Pediatric retinal photograph (wide-field):
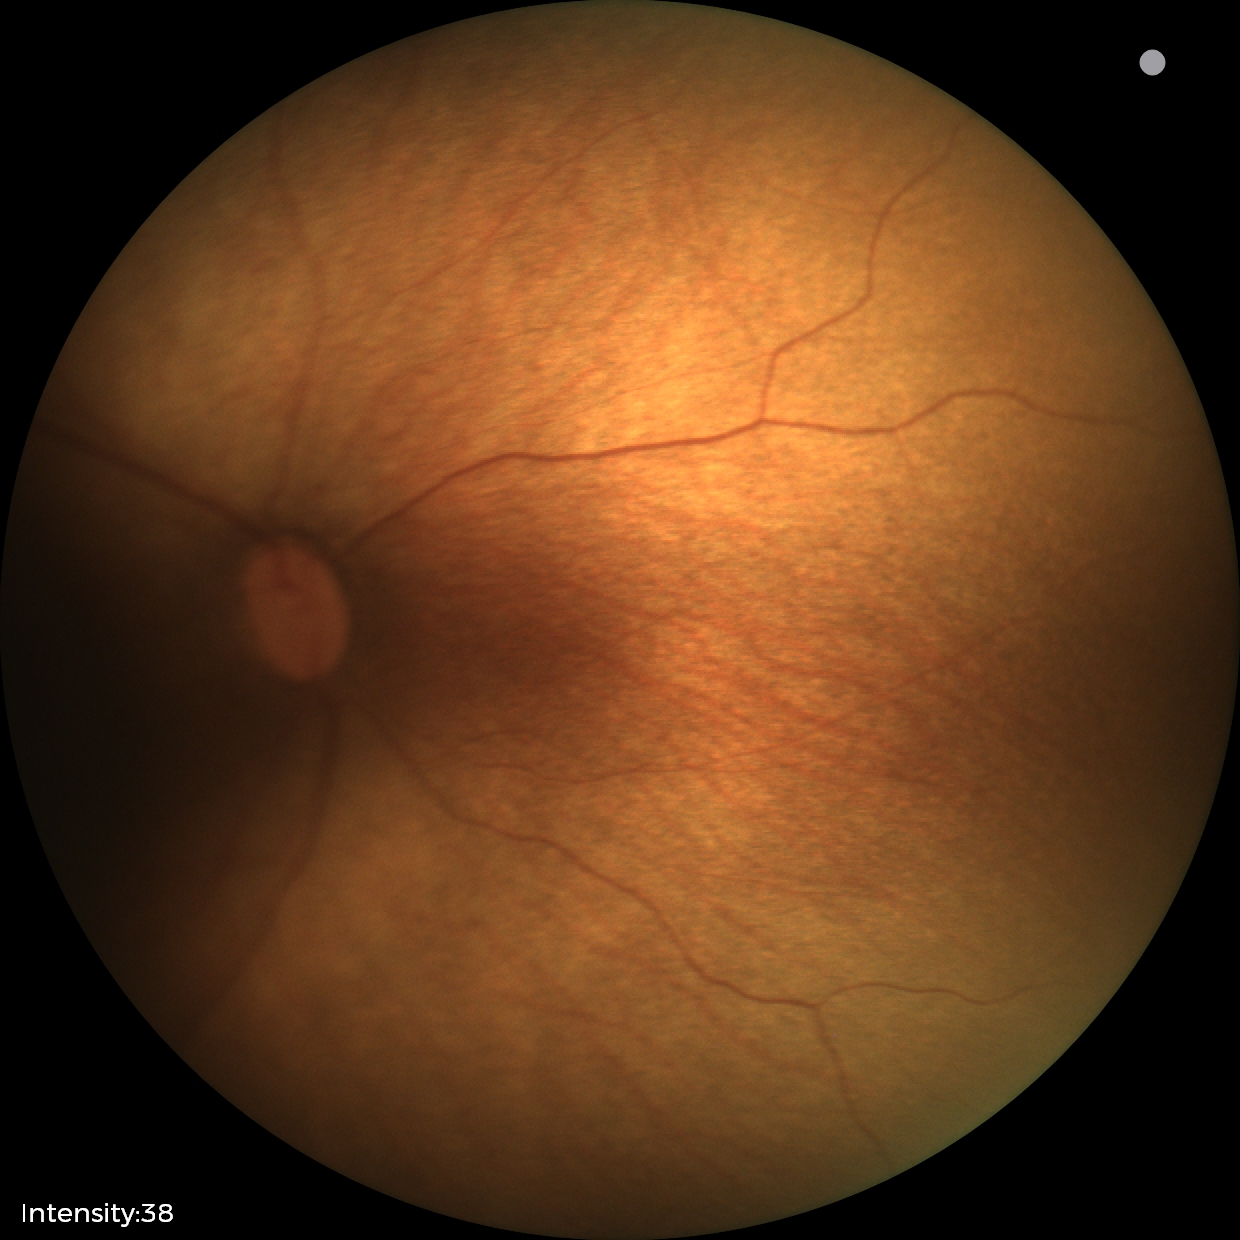

Without plus disease.
Diagnosis from this screening exam: status post retinopathy of prematurity (ROP).